CFP.
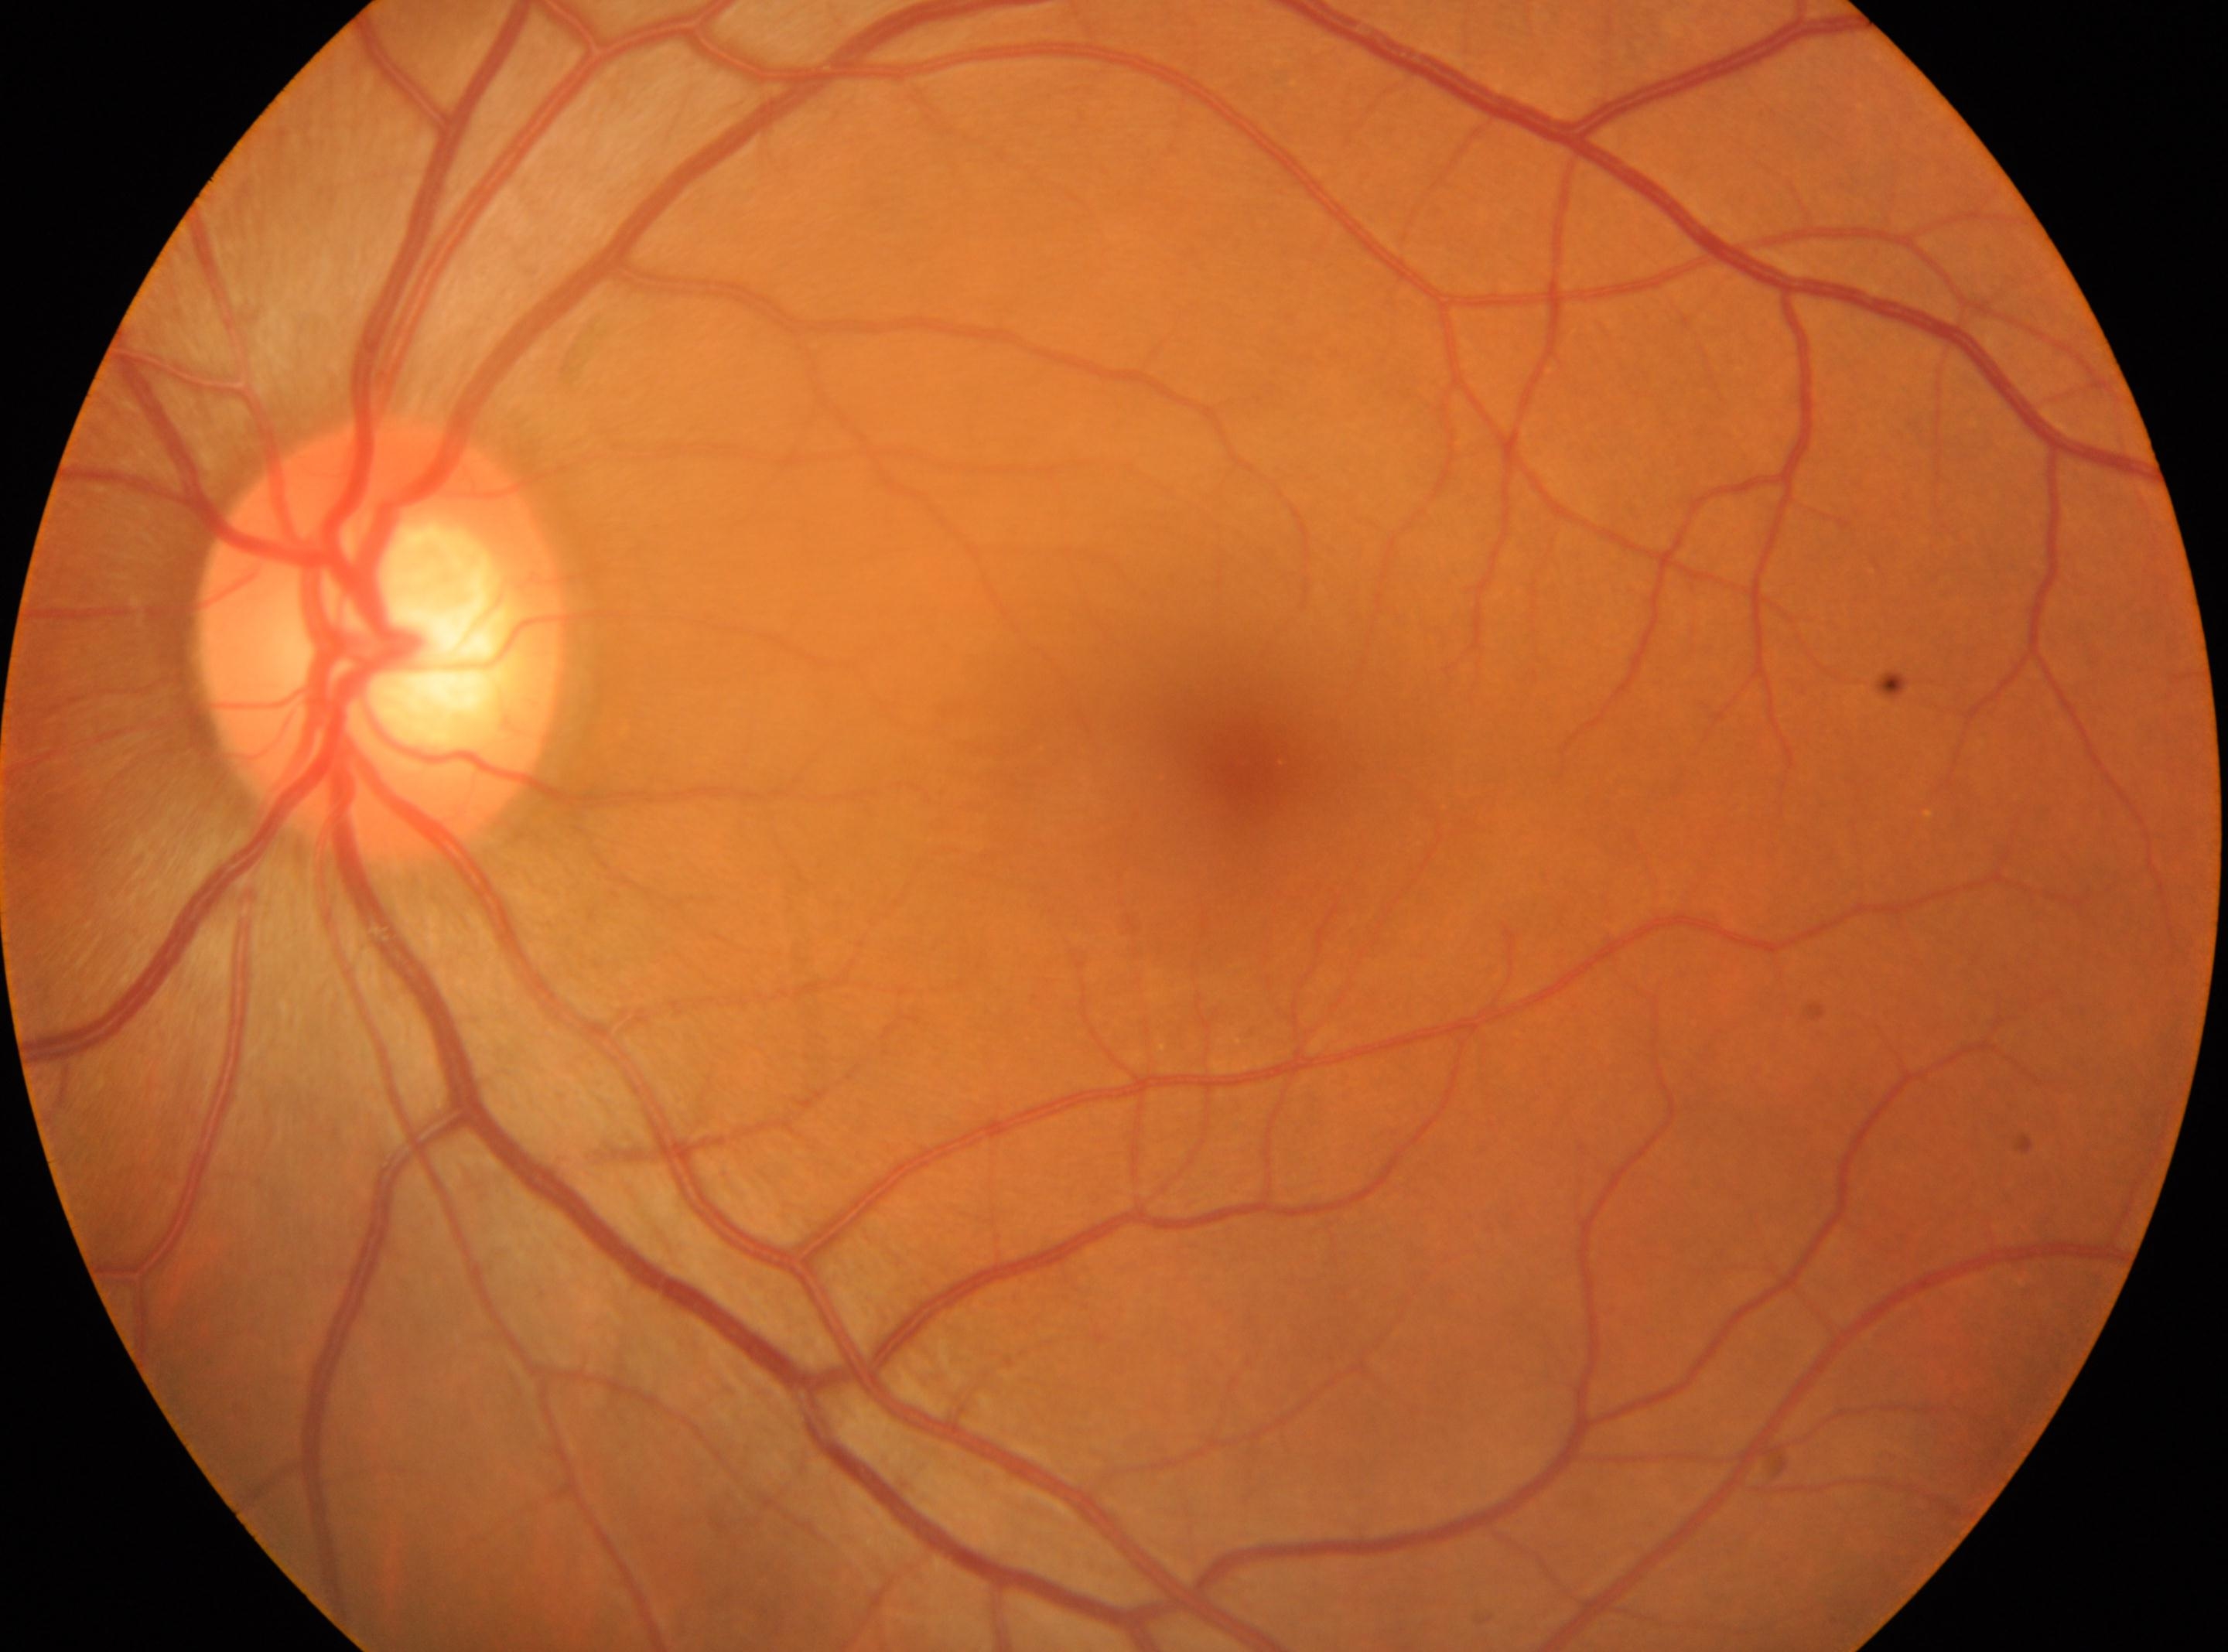

laterality: oculus sinister; ONH: (378, 639); macular center: (1242, 763); diabetic retinopathy: grade 0 (no apparent retinopathy); DR impression: No diabetic retinal disease findings.